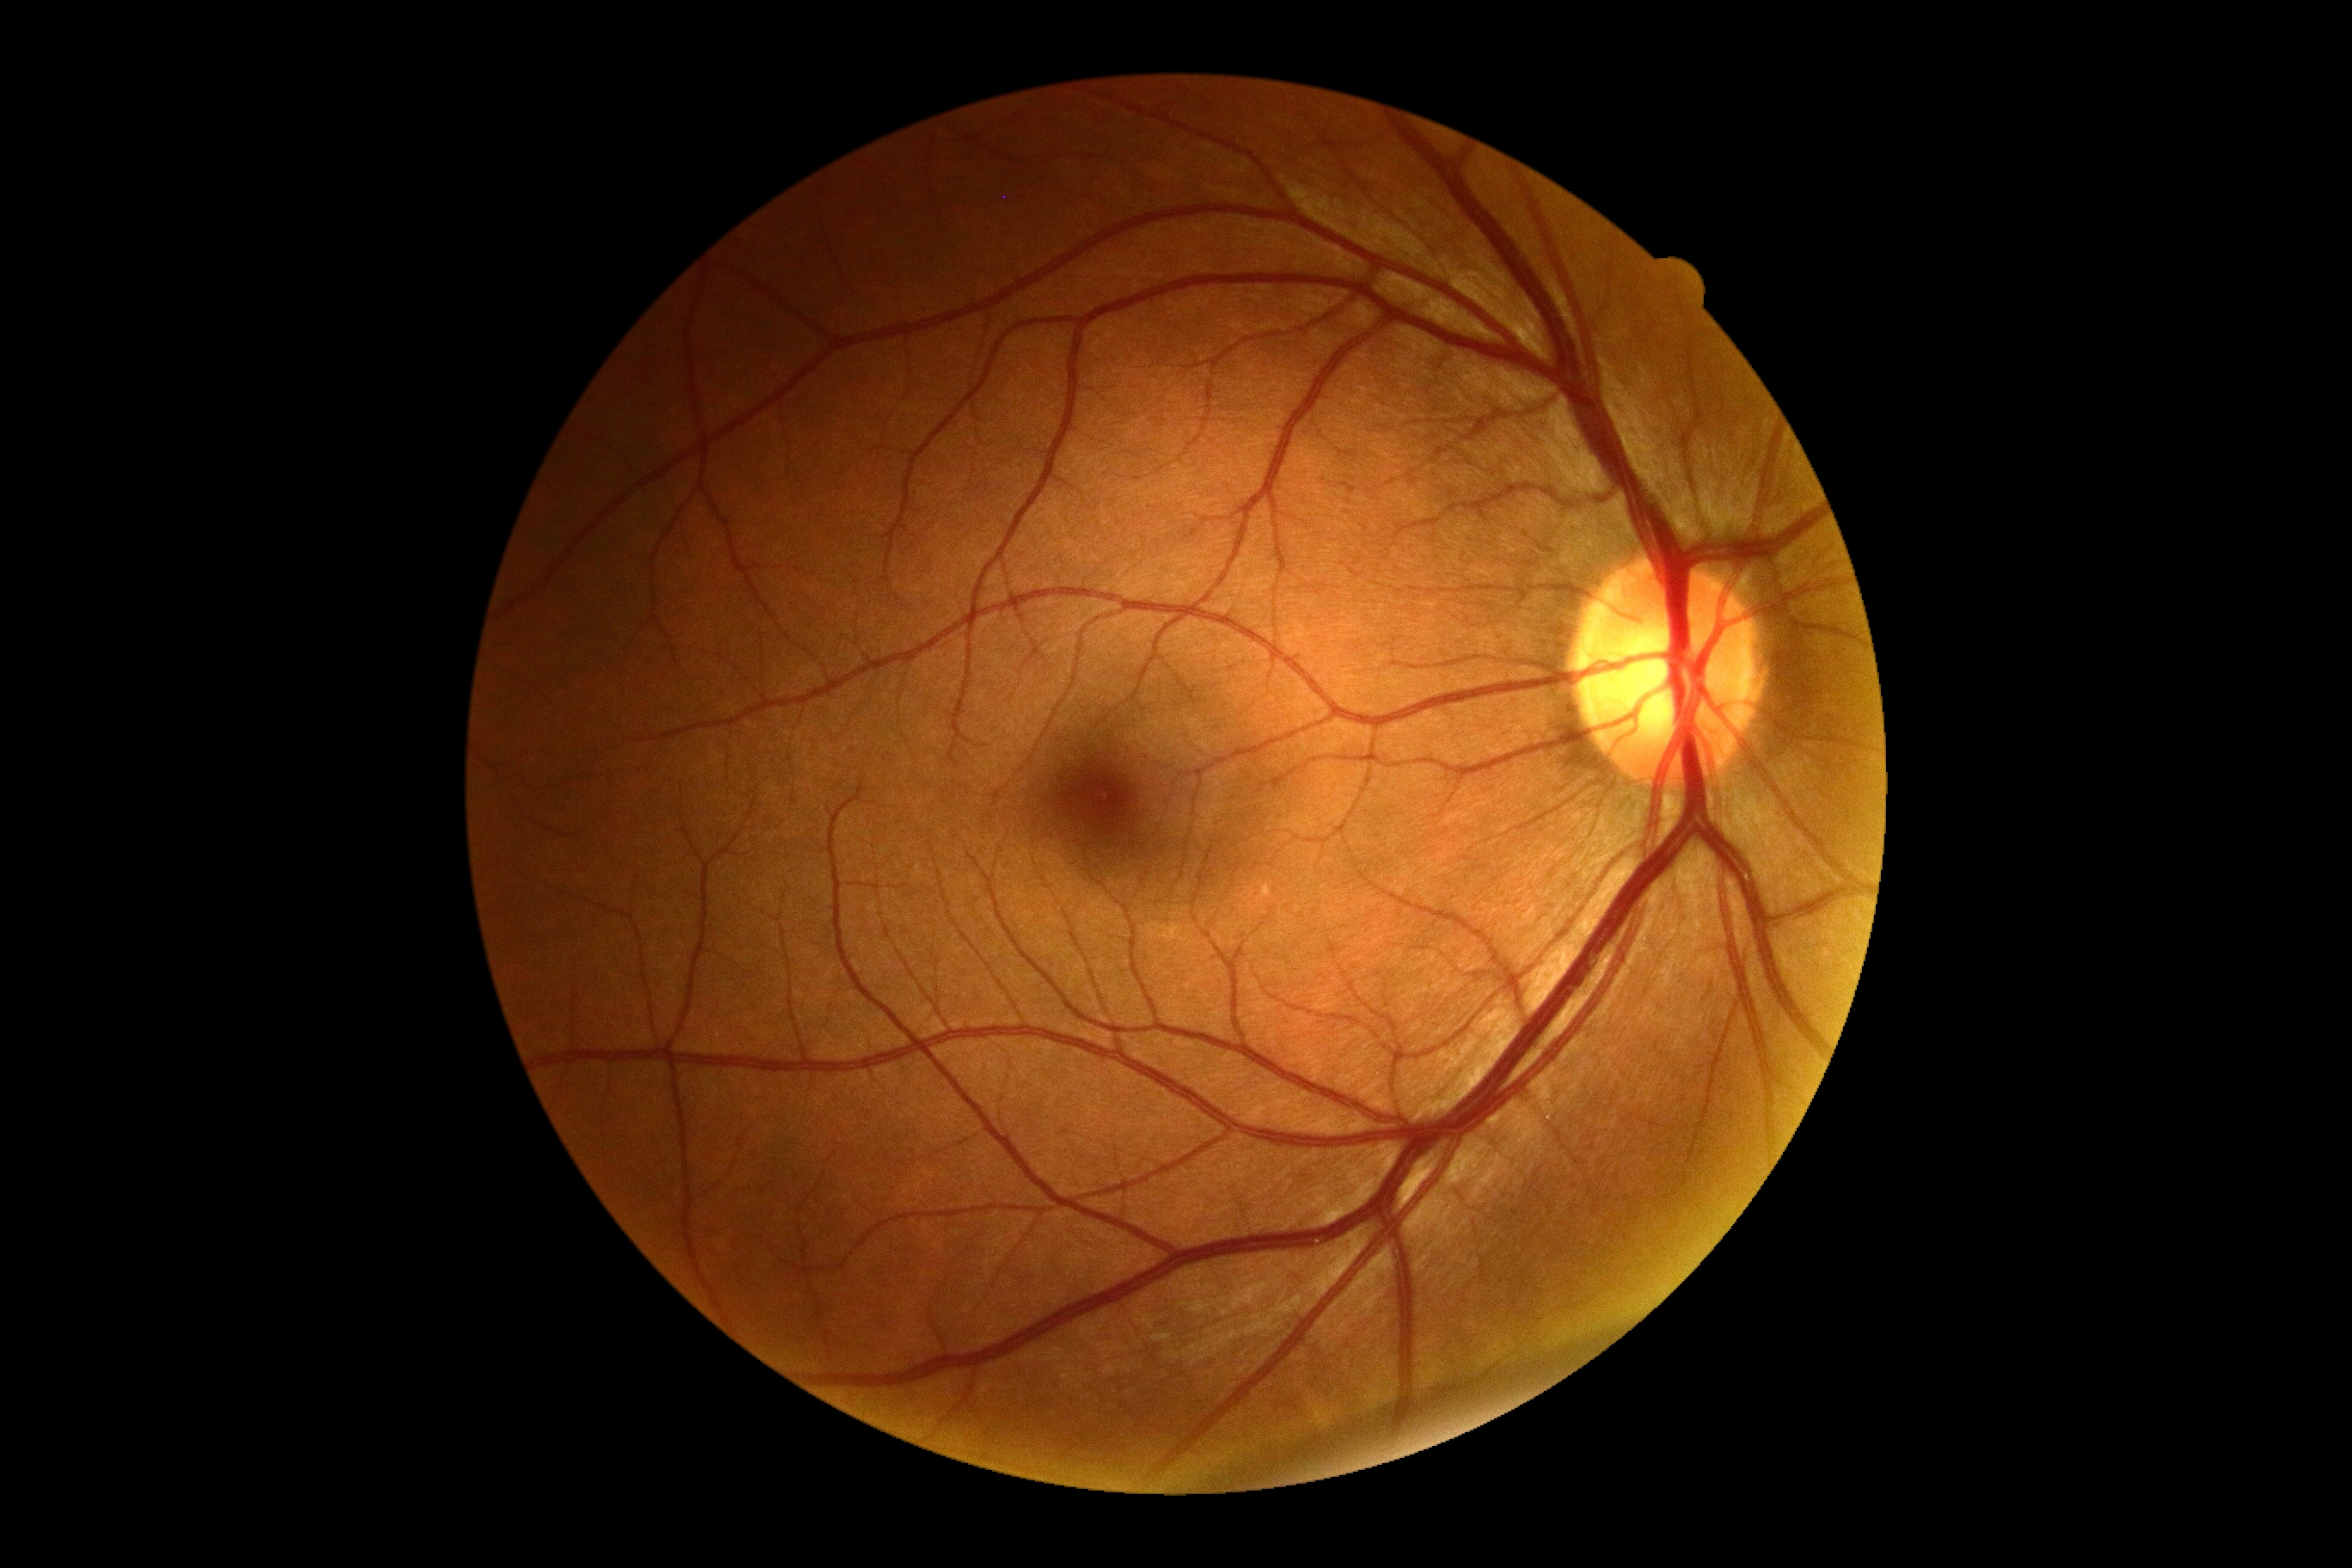   dr_grade: no apparent retinopathy (0)
  dr_impression: negative for DR